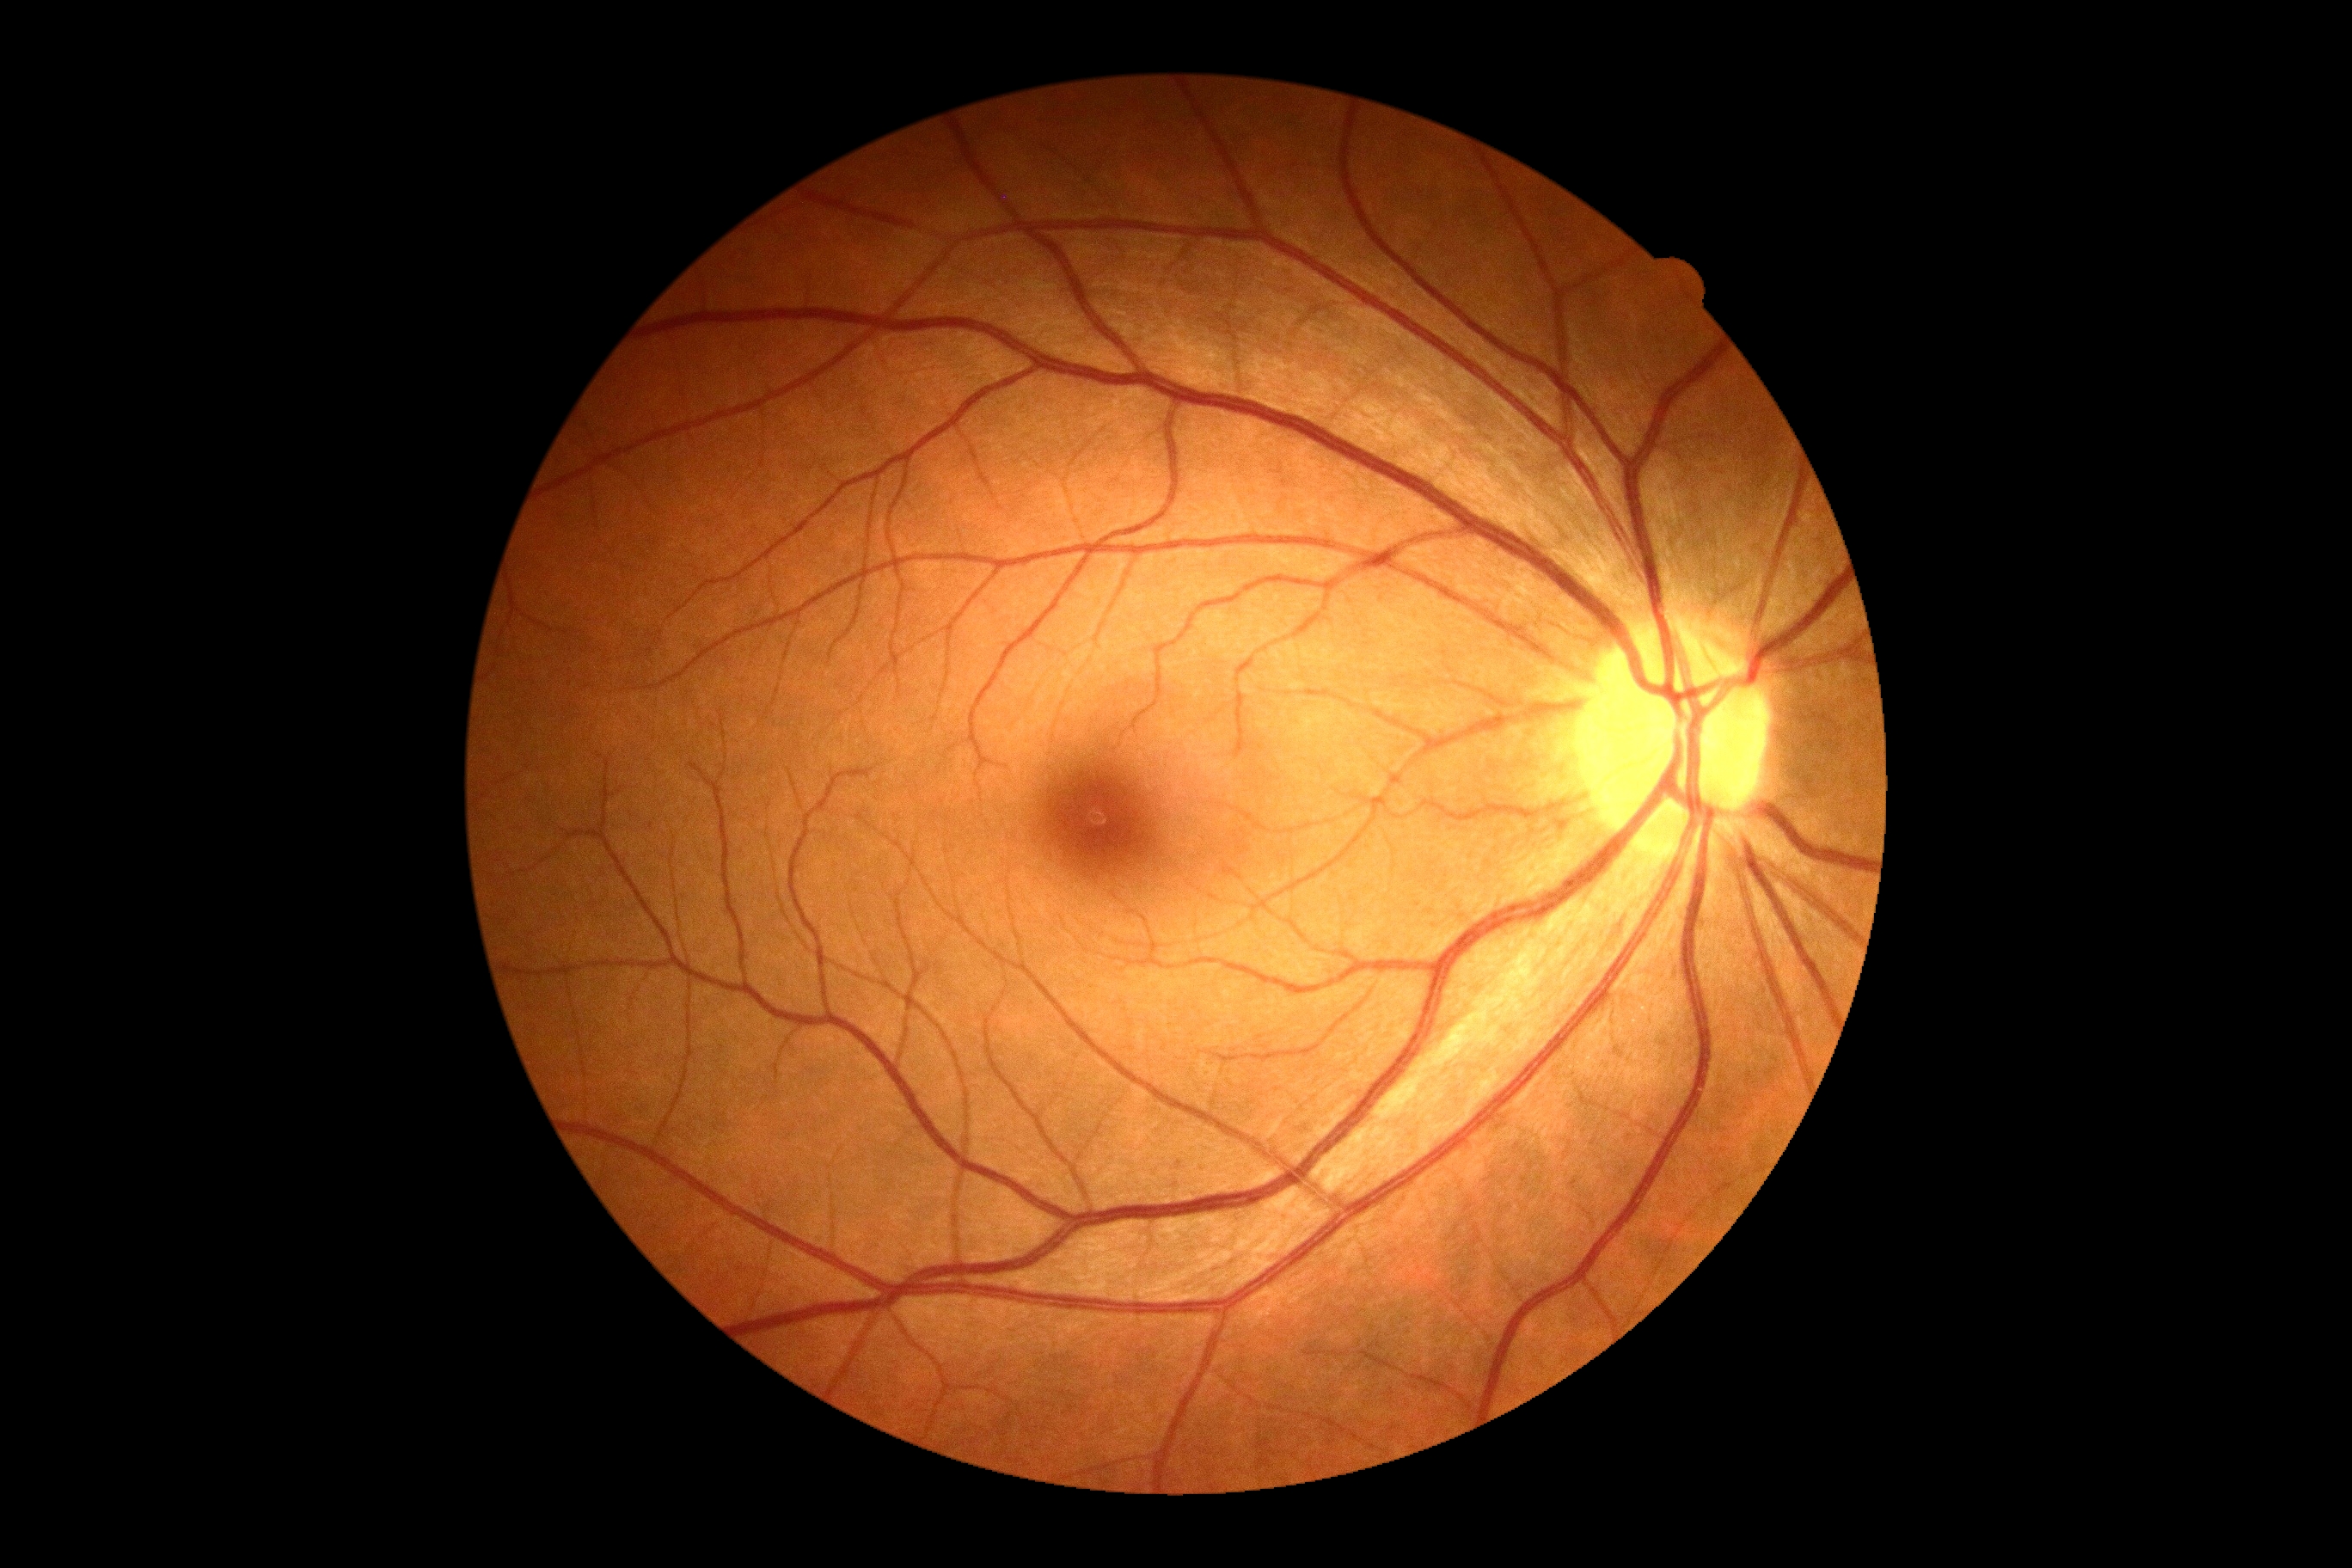   dr_grade: no apparent diabetic retinopathy (grade 0)